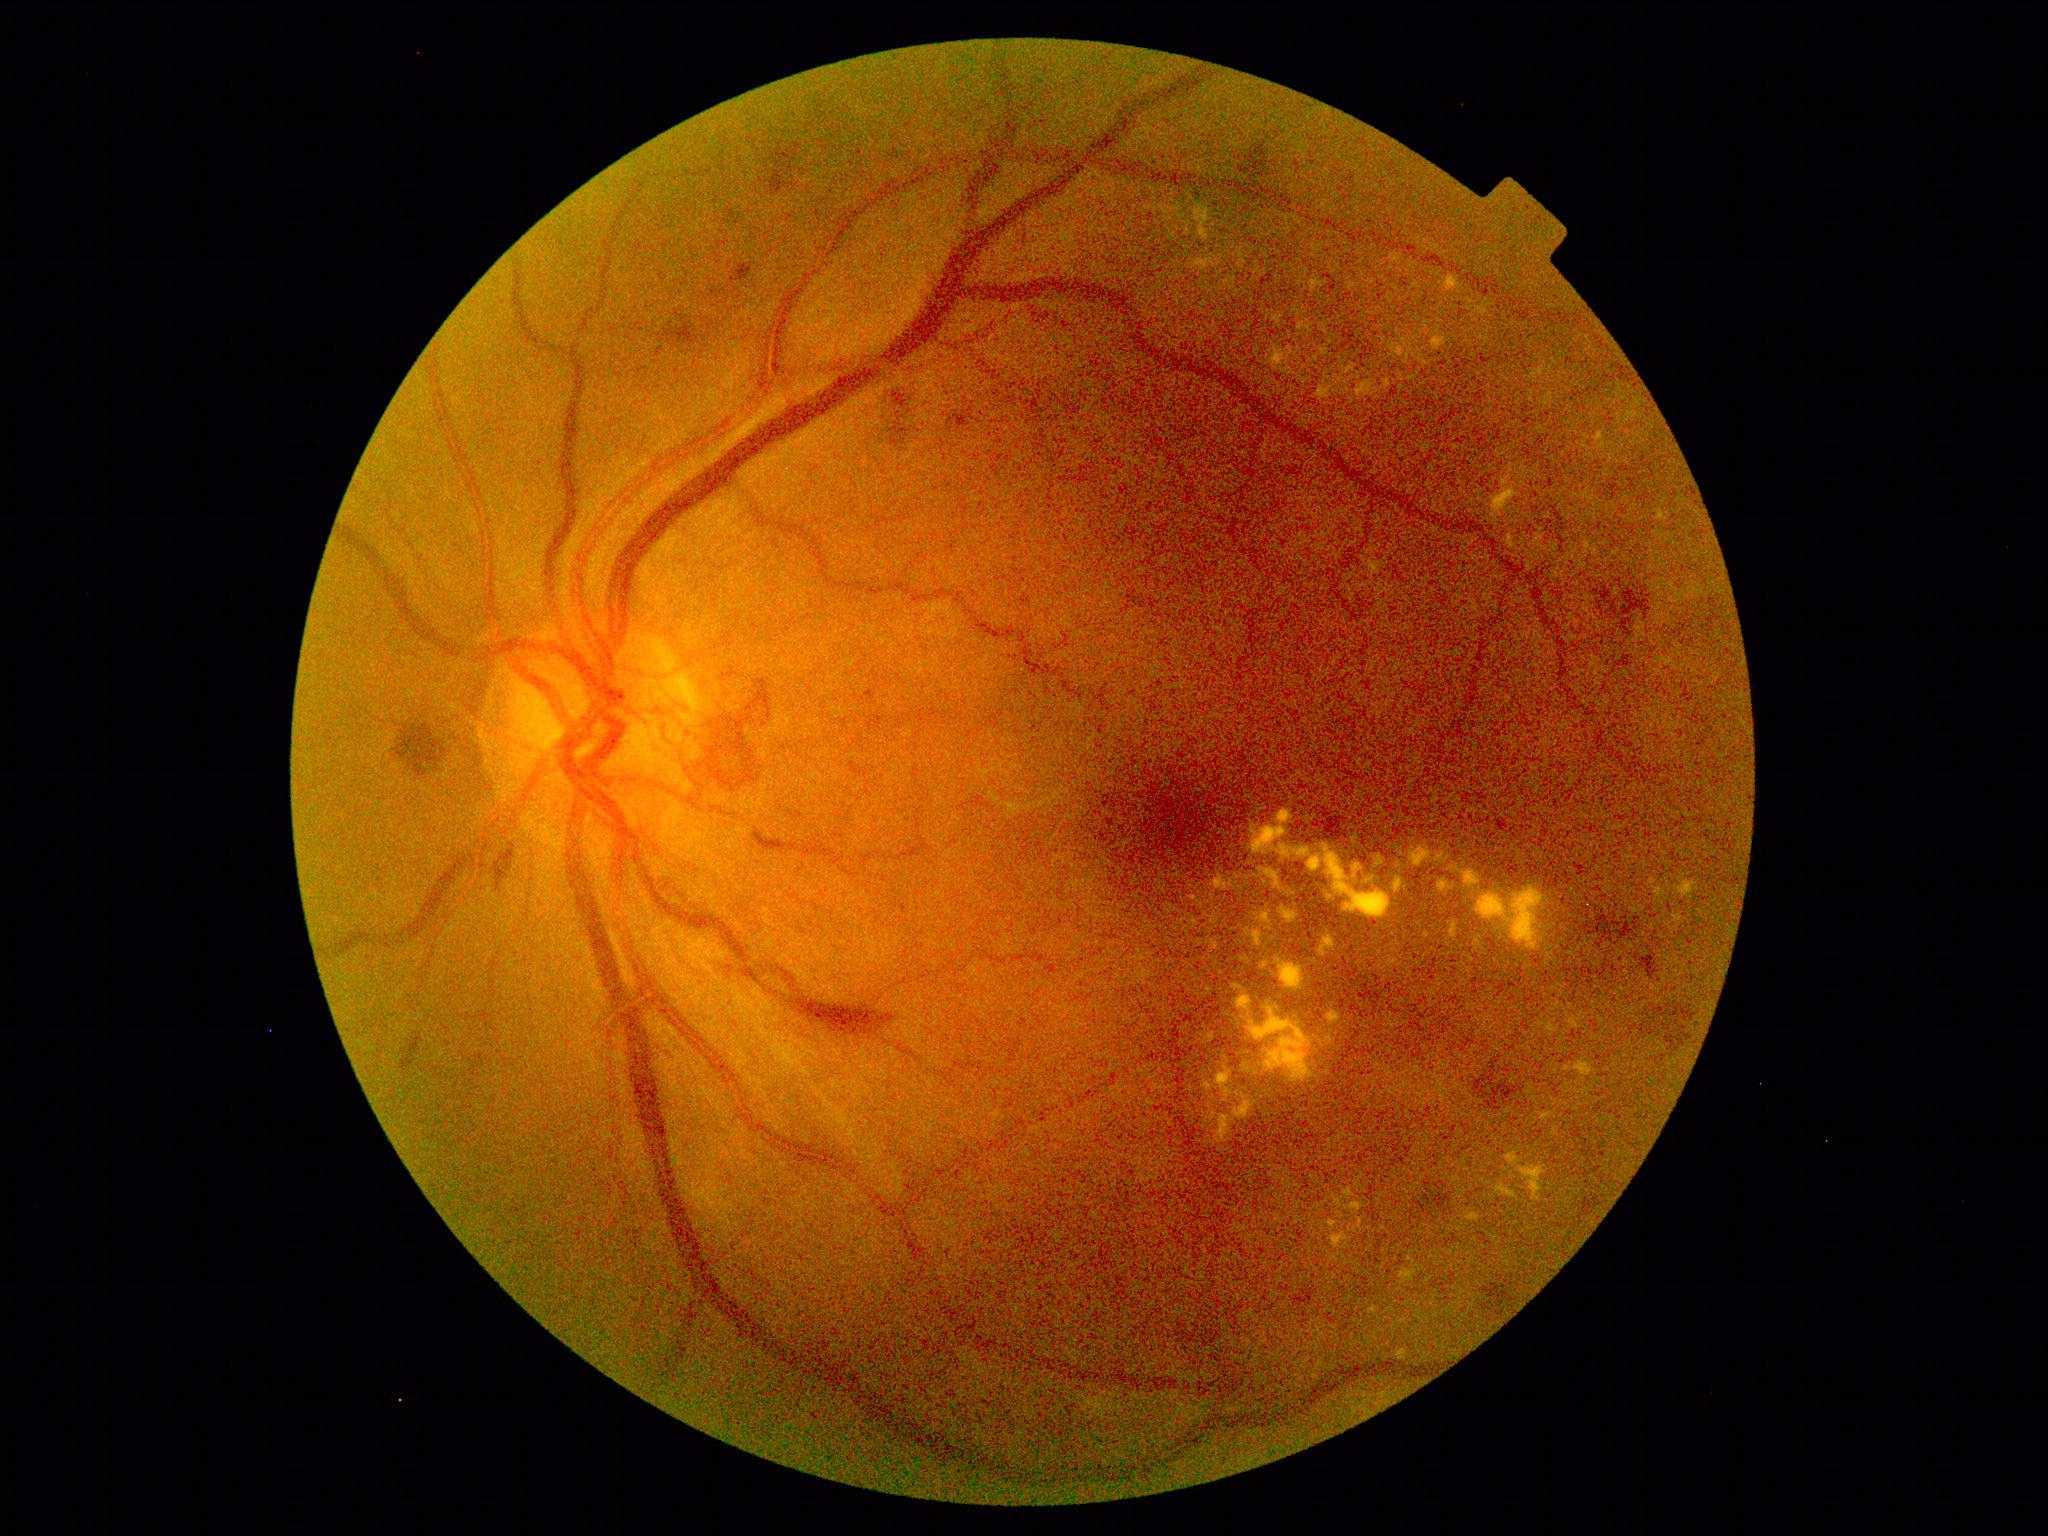 DR: proliferative diabetic retinopathy (grade 4). The retinopathy is classified as proliferative diabetic retinopathy.